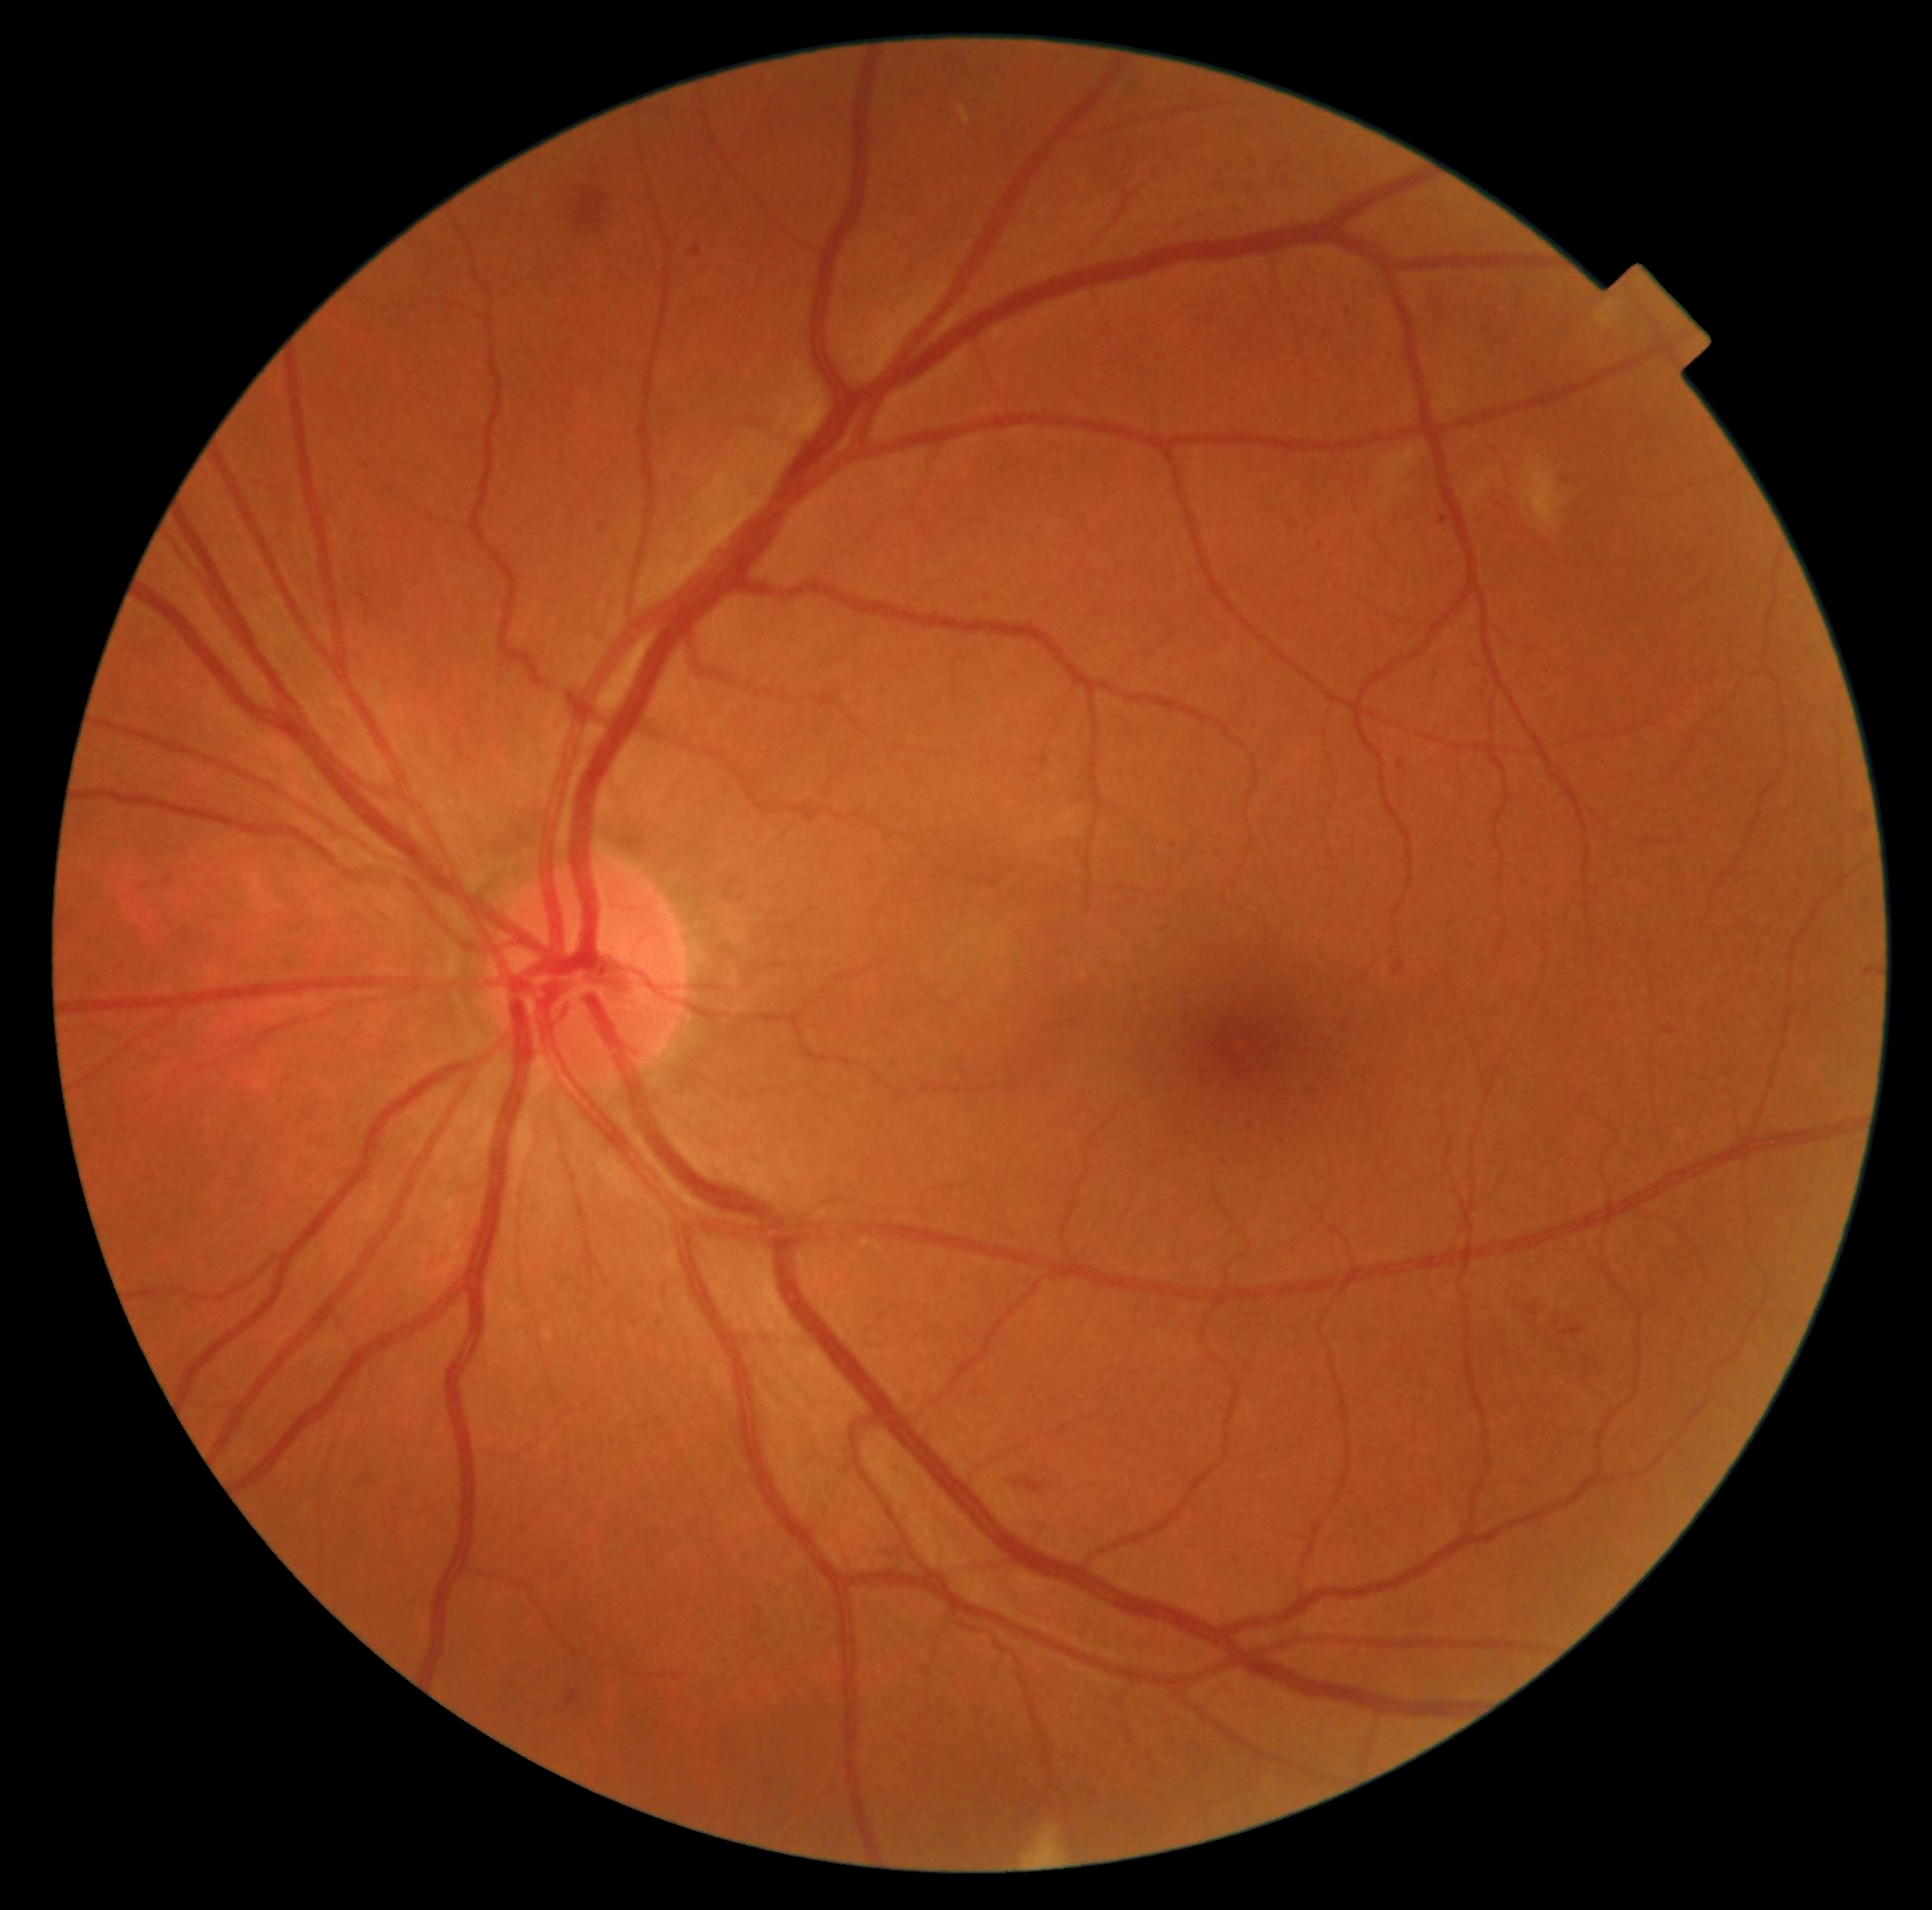

retinopathy: moderate NPDR (grade 2); DR class: non-proliferative diabetic retinopathy.